60° FOV · handheld portable fundus camera image: 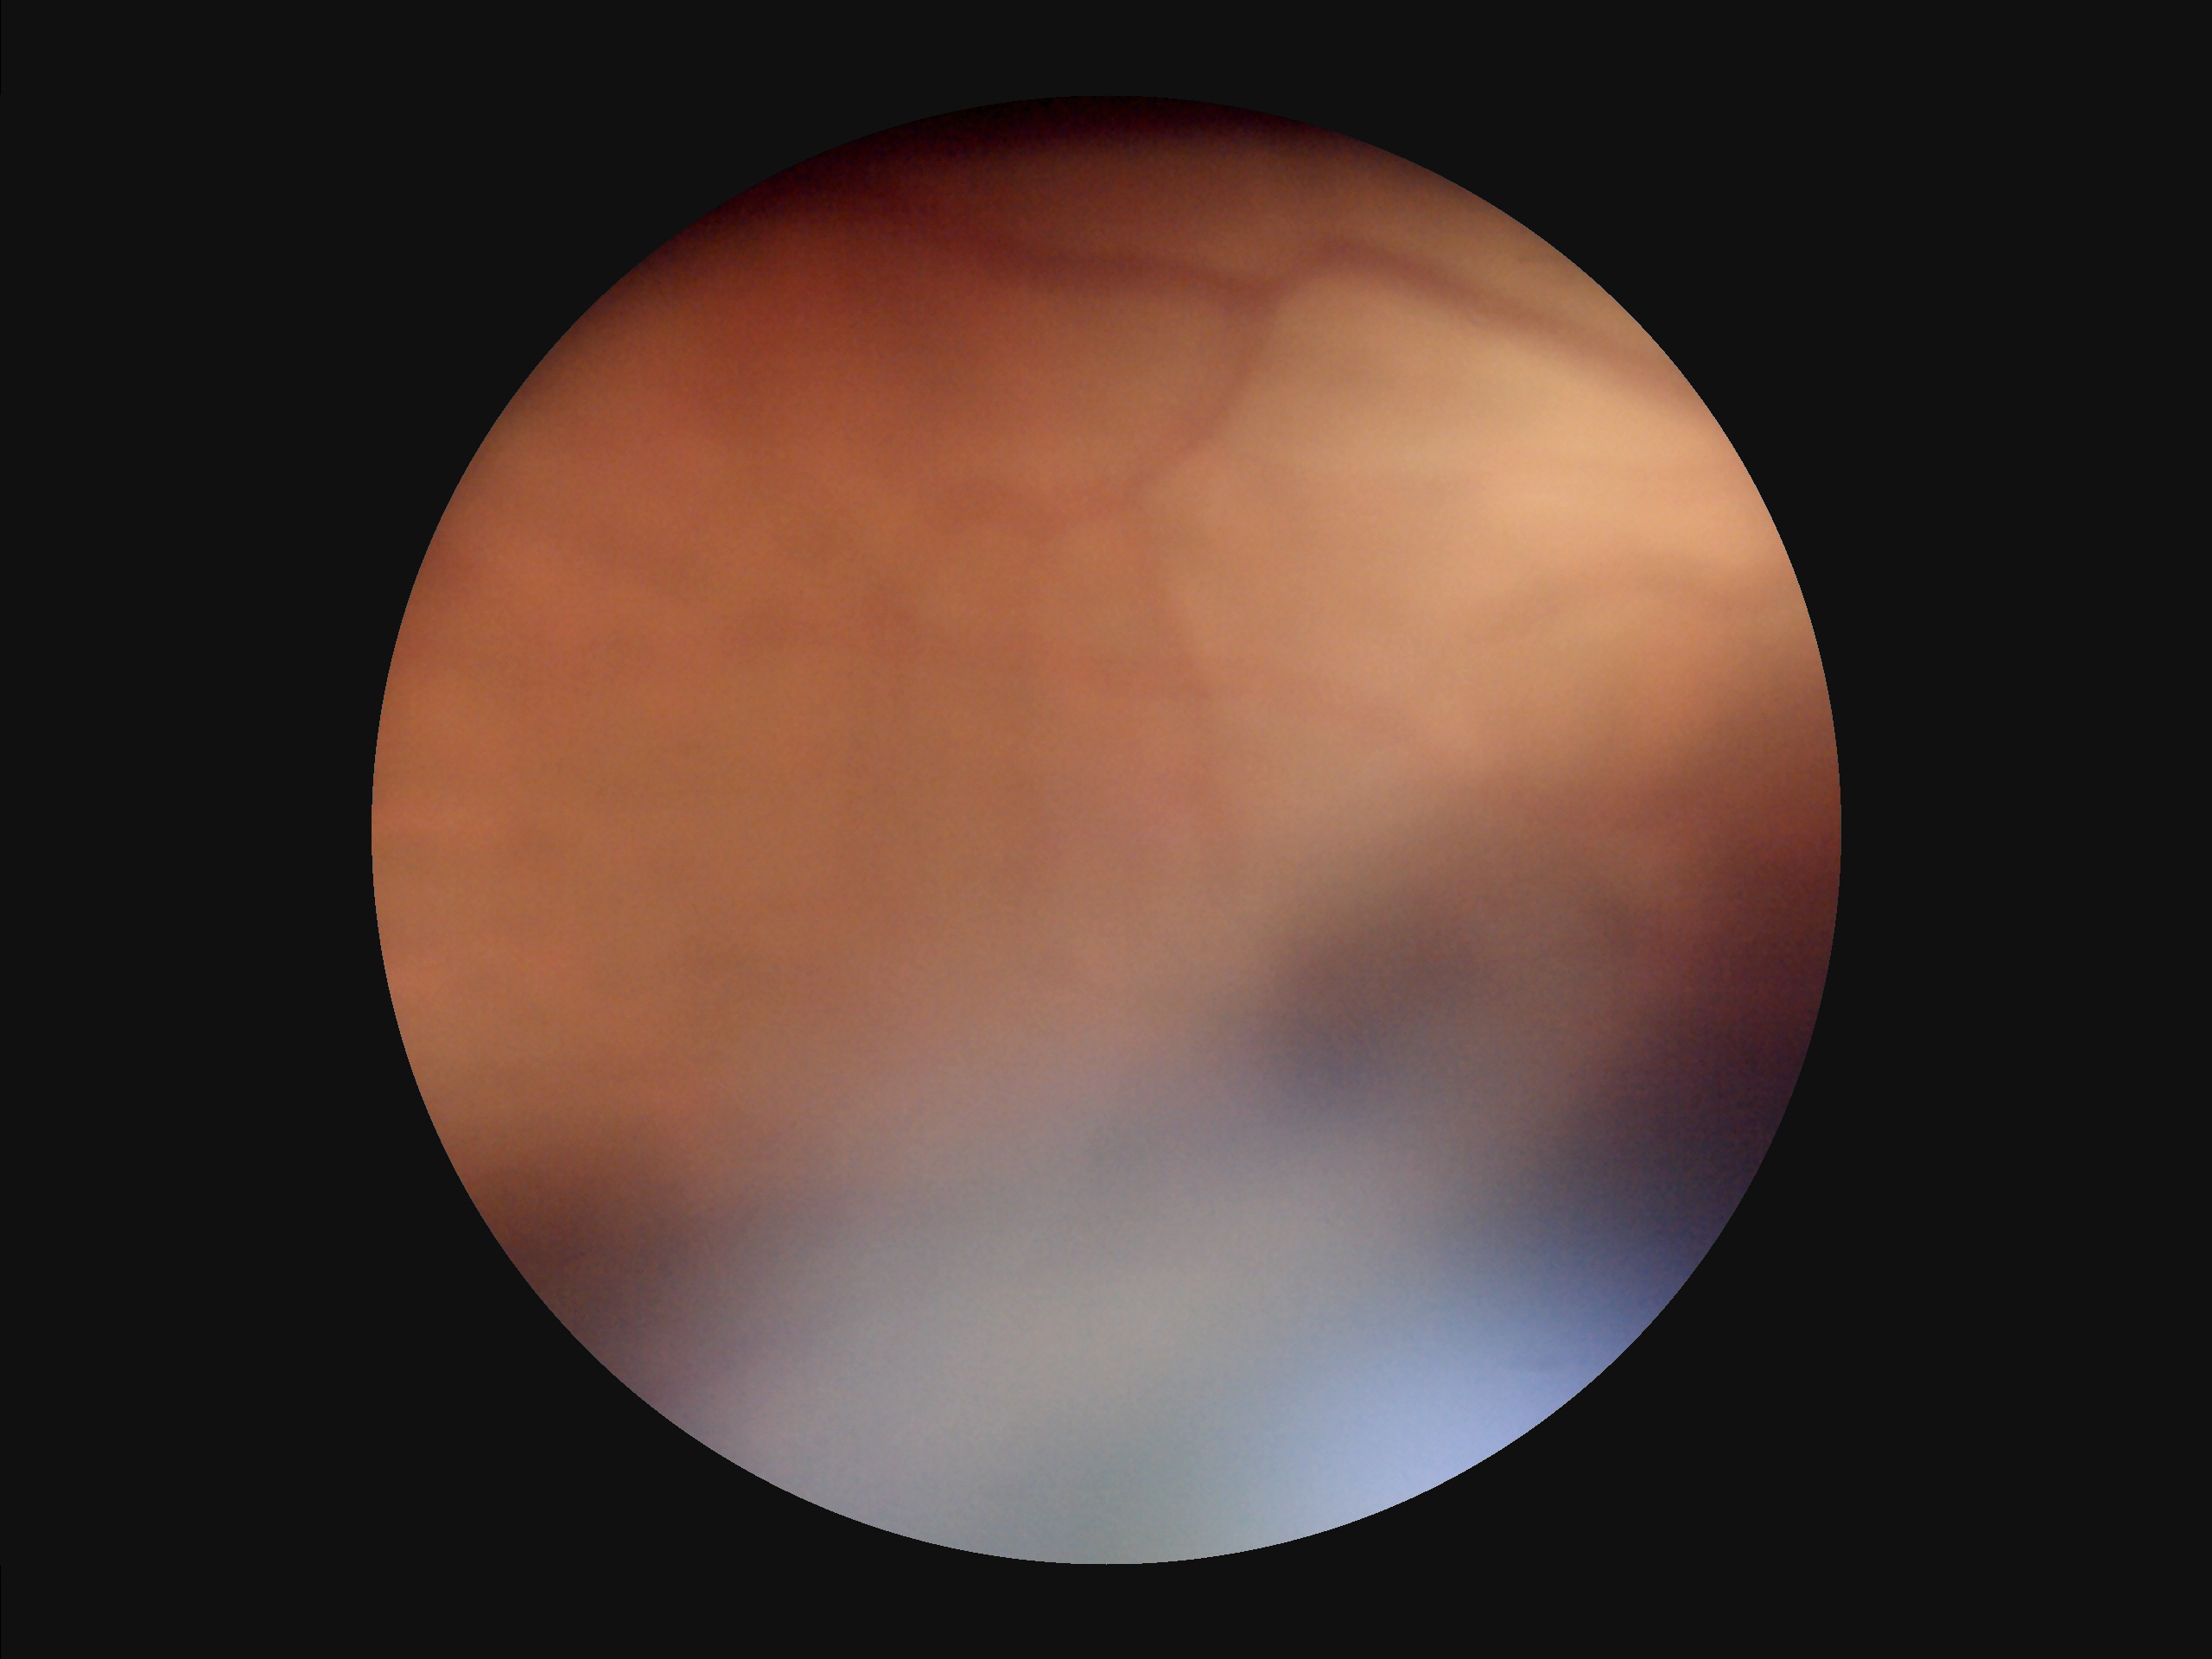 Quality assessment: contrast: poor | sharpness: blurry | illumination: suboptimal | overall: poor.